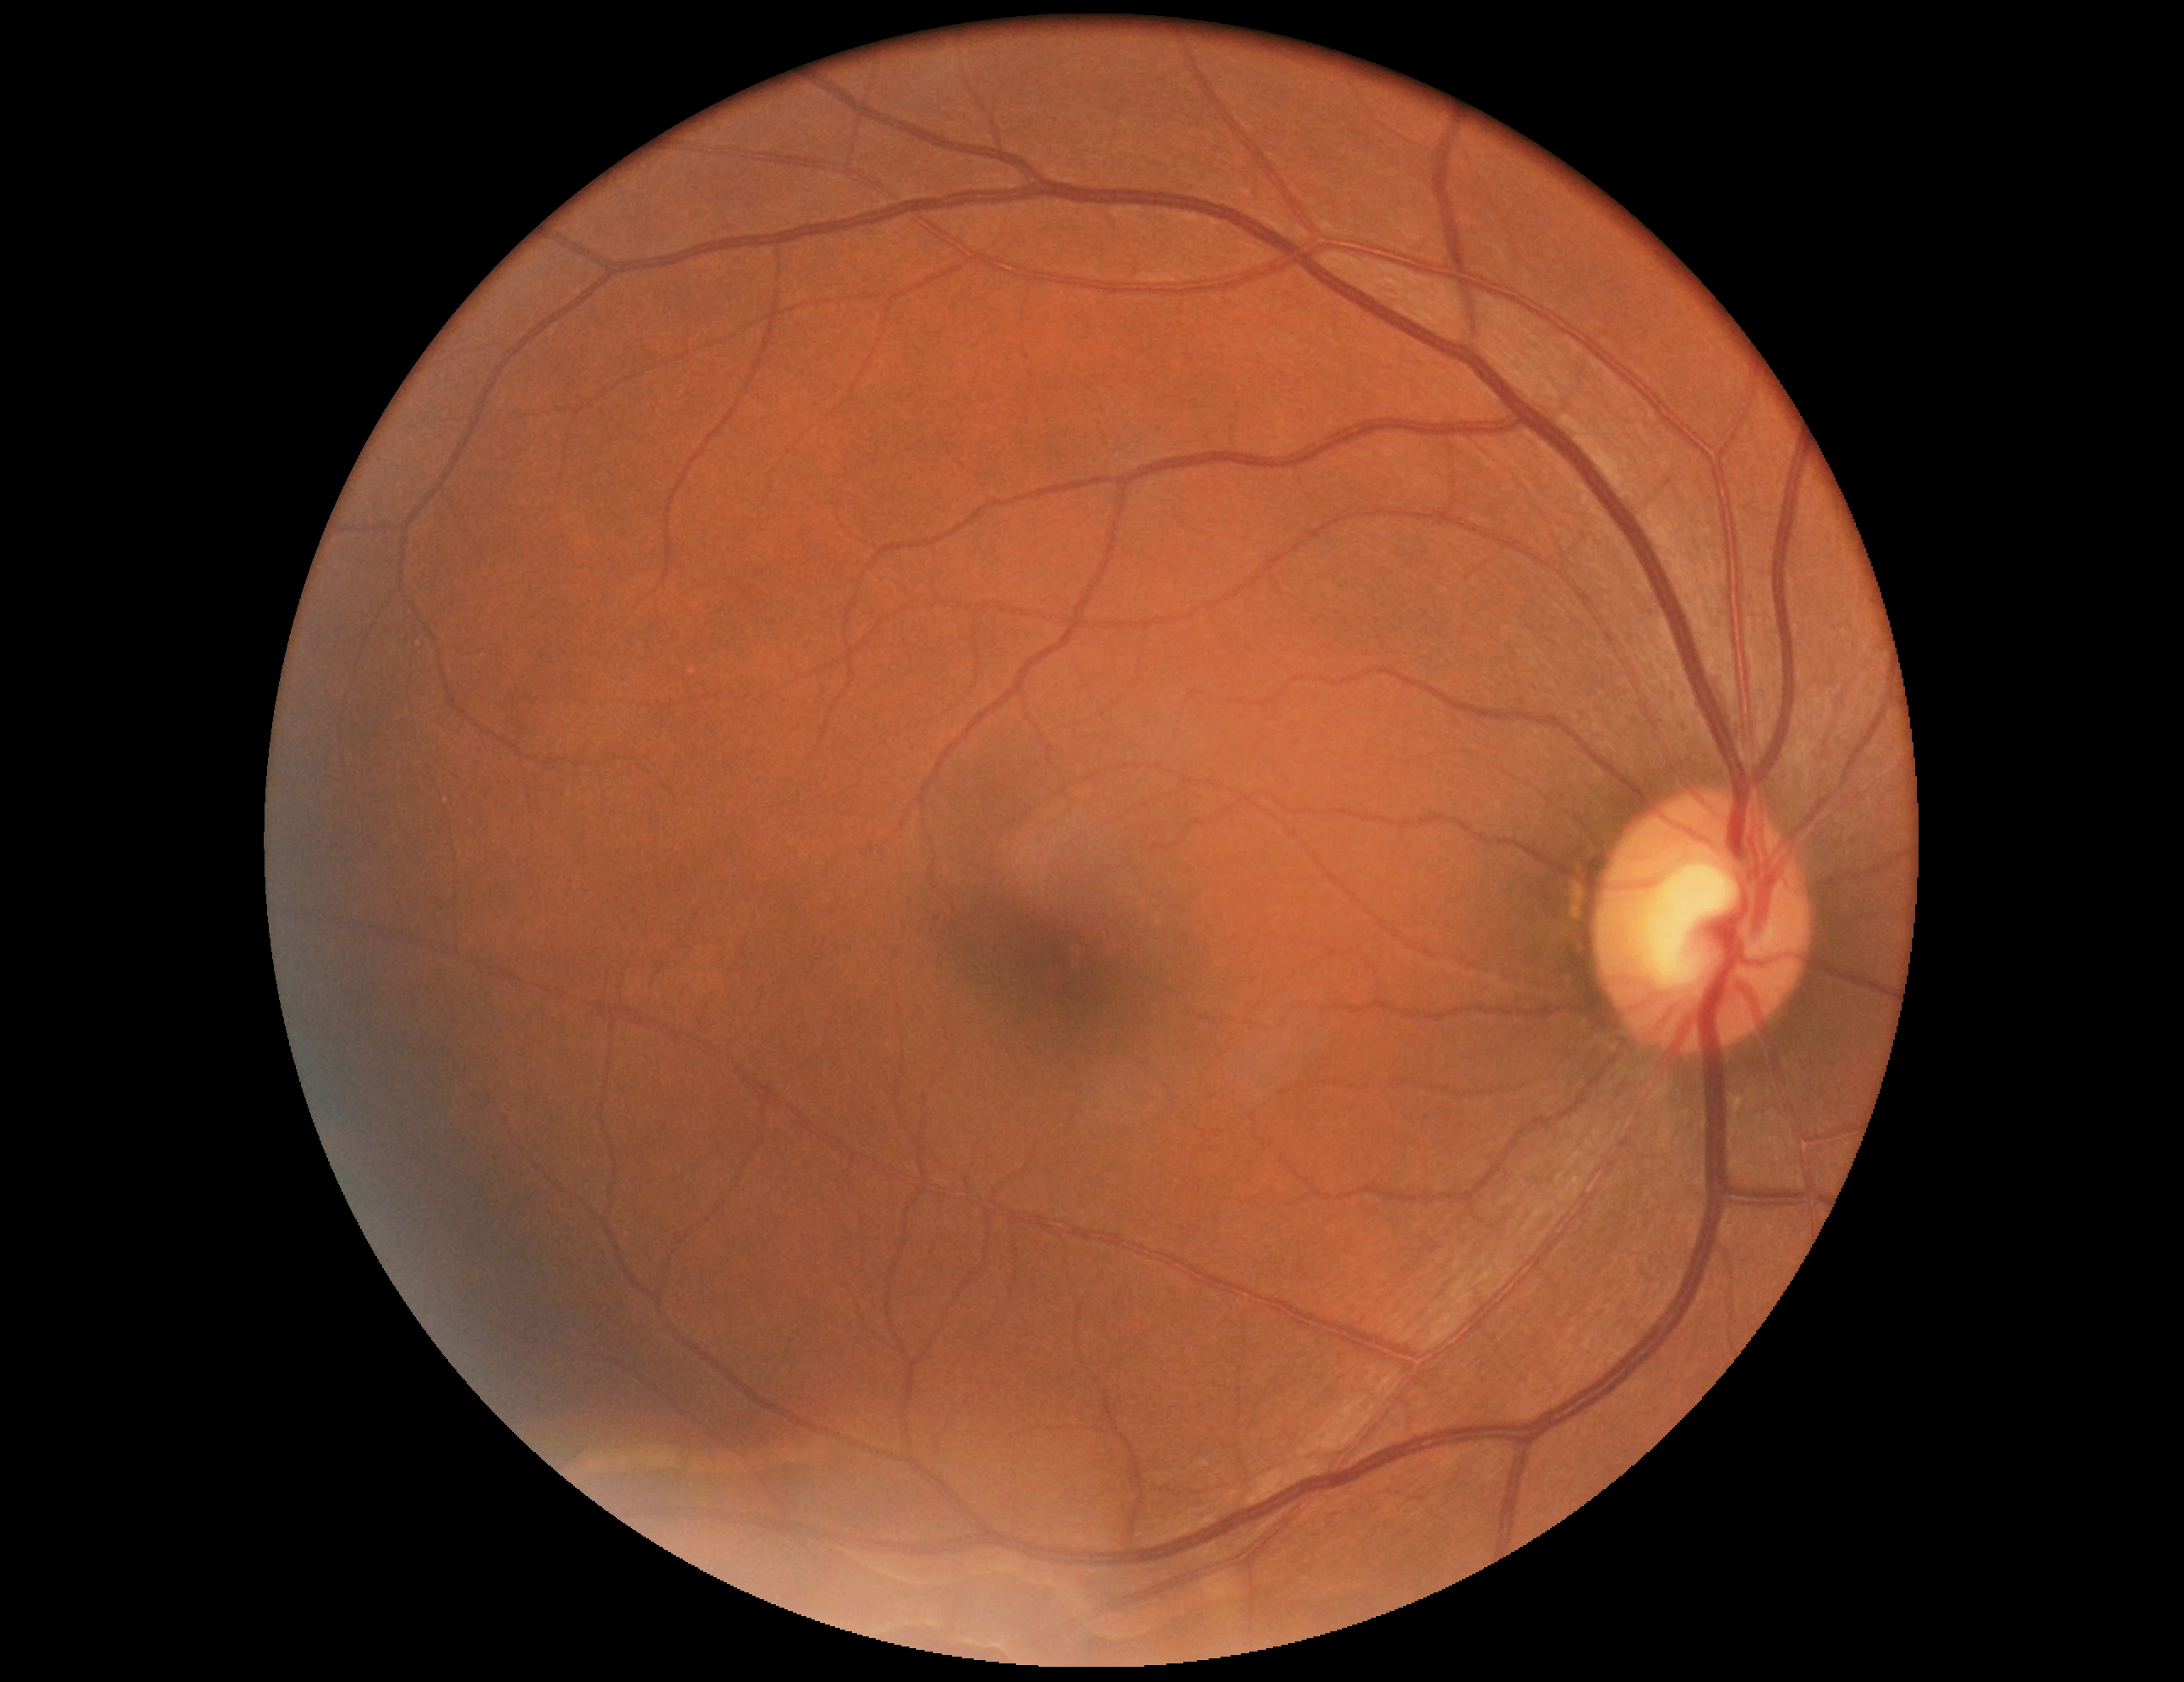
Findings:
– diabetic retinopathy (DR): 0/4 — no visible signs of diabetic retinopathy